45-degree field of view; retinal fundus photograph — 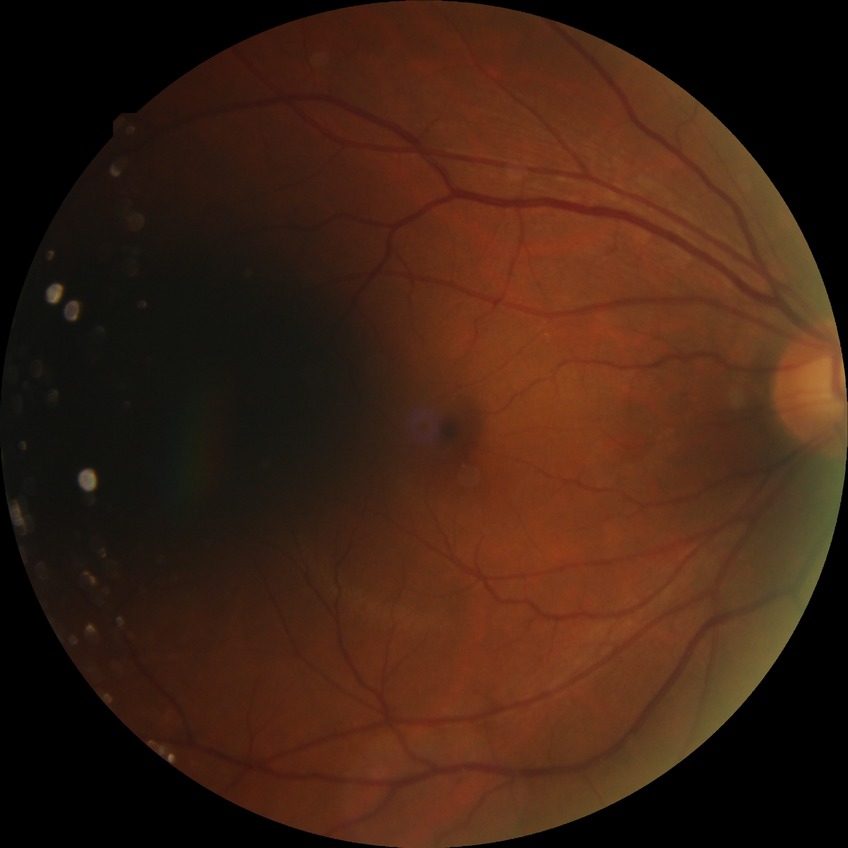
Davis grading: no diabetic retinopathy.